Graded on the modified Davis scale.
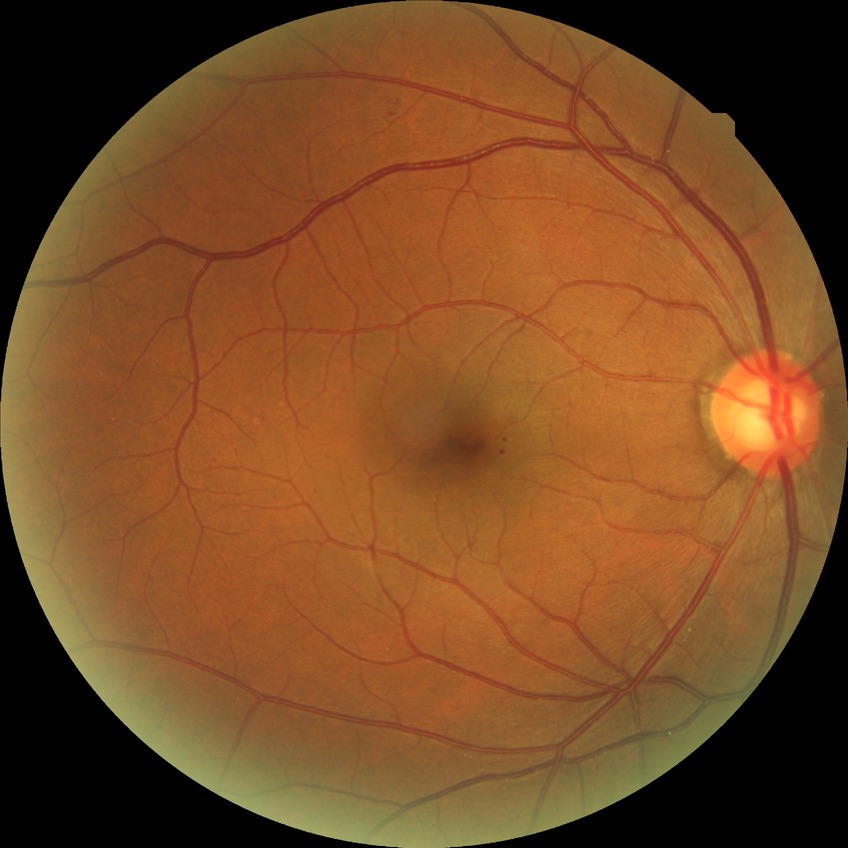

Retinopathy stage is simple diabetic retinopathy.